45° field of view:
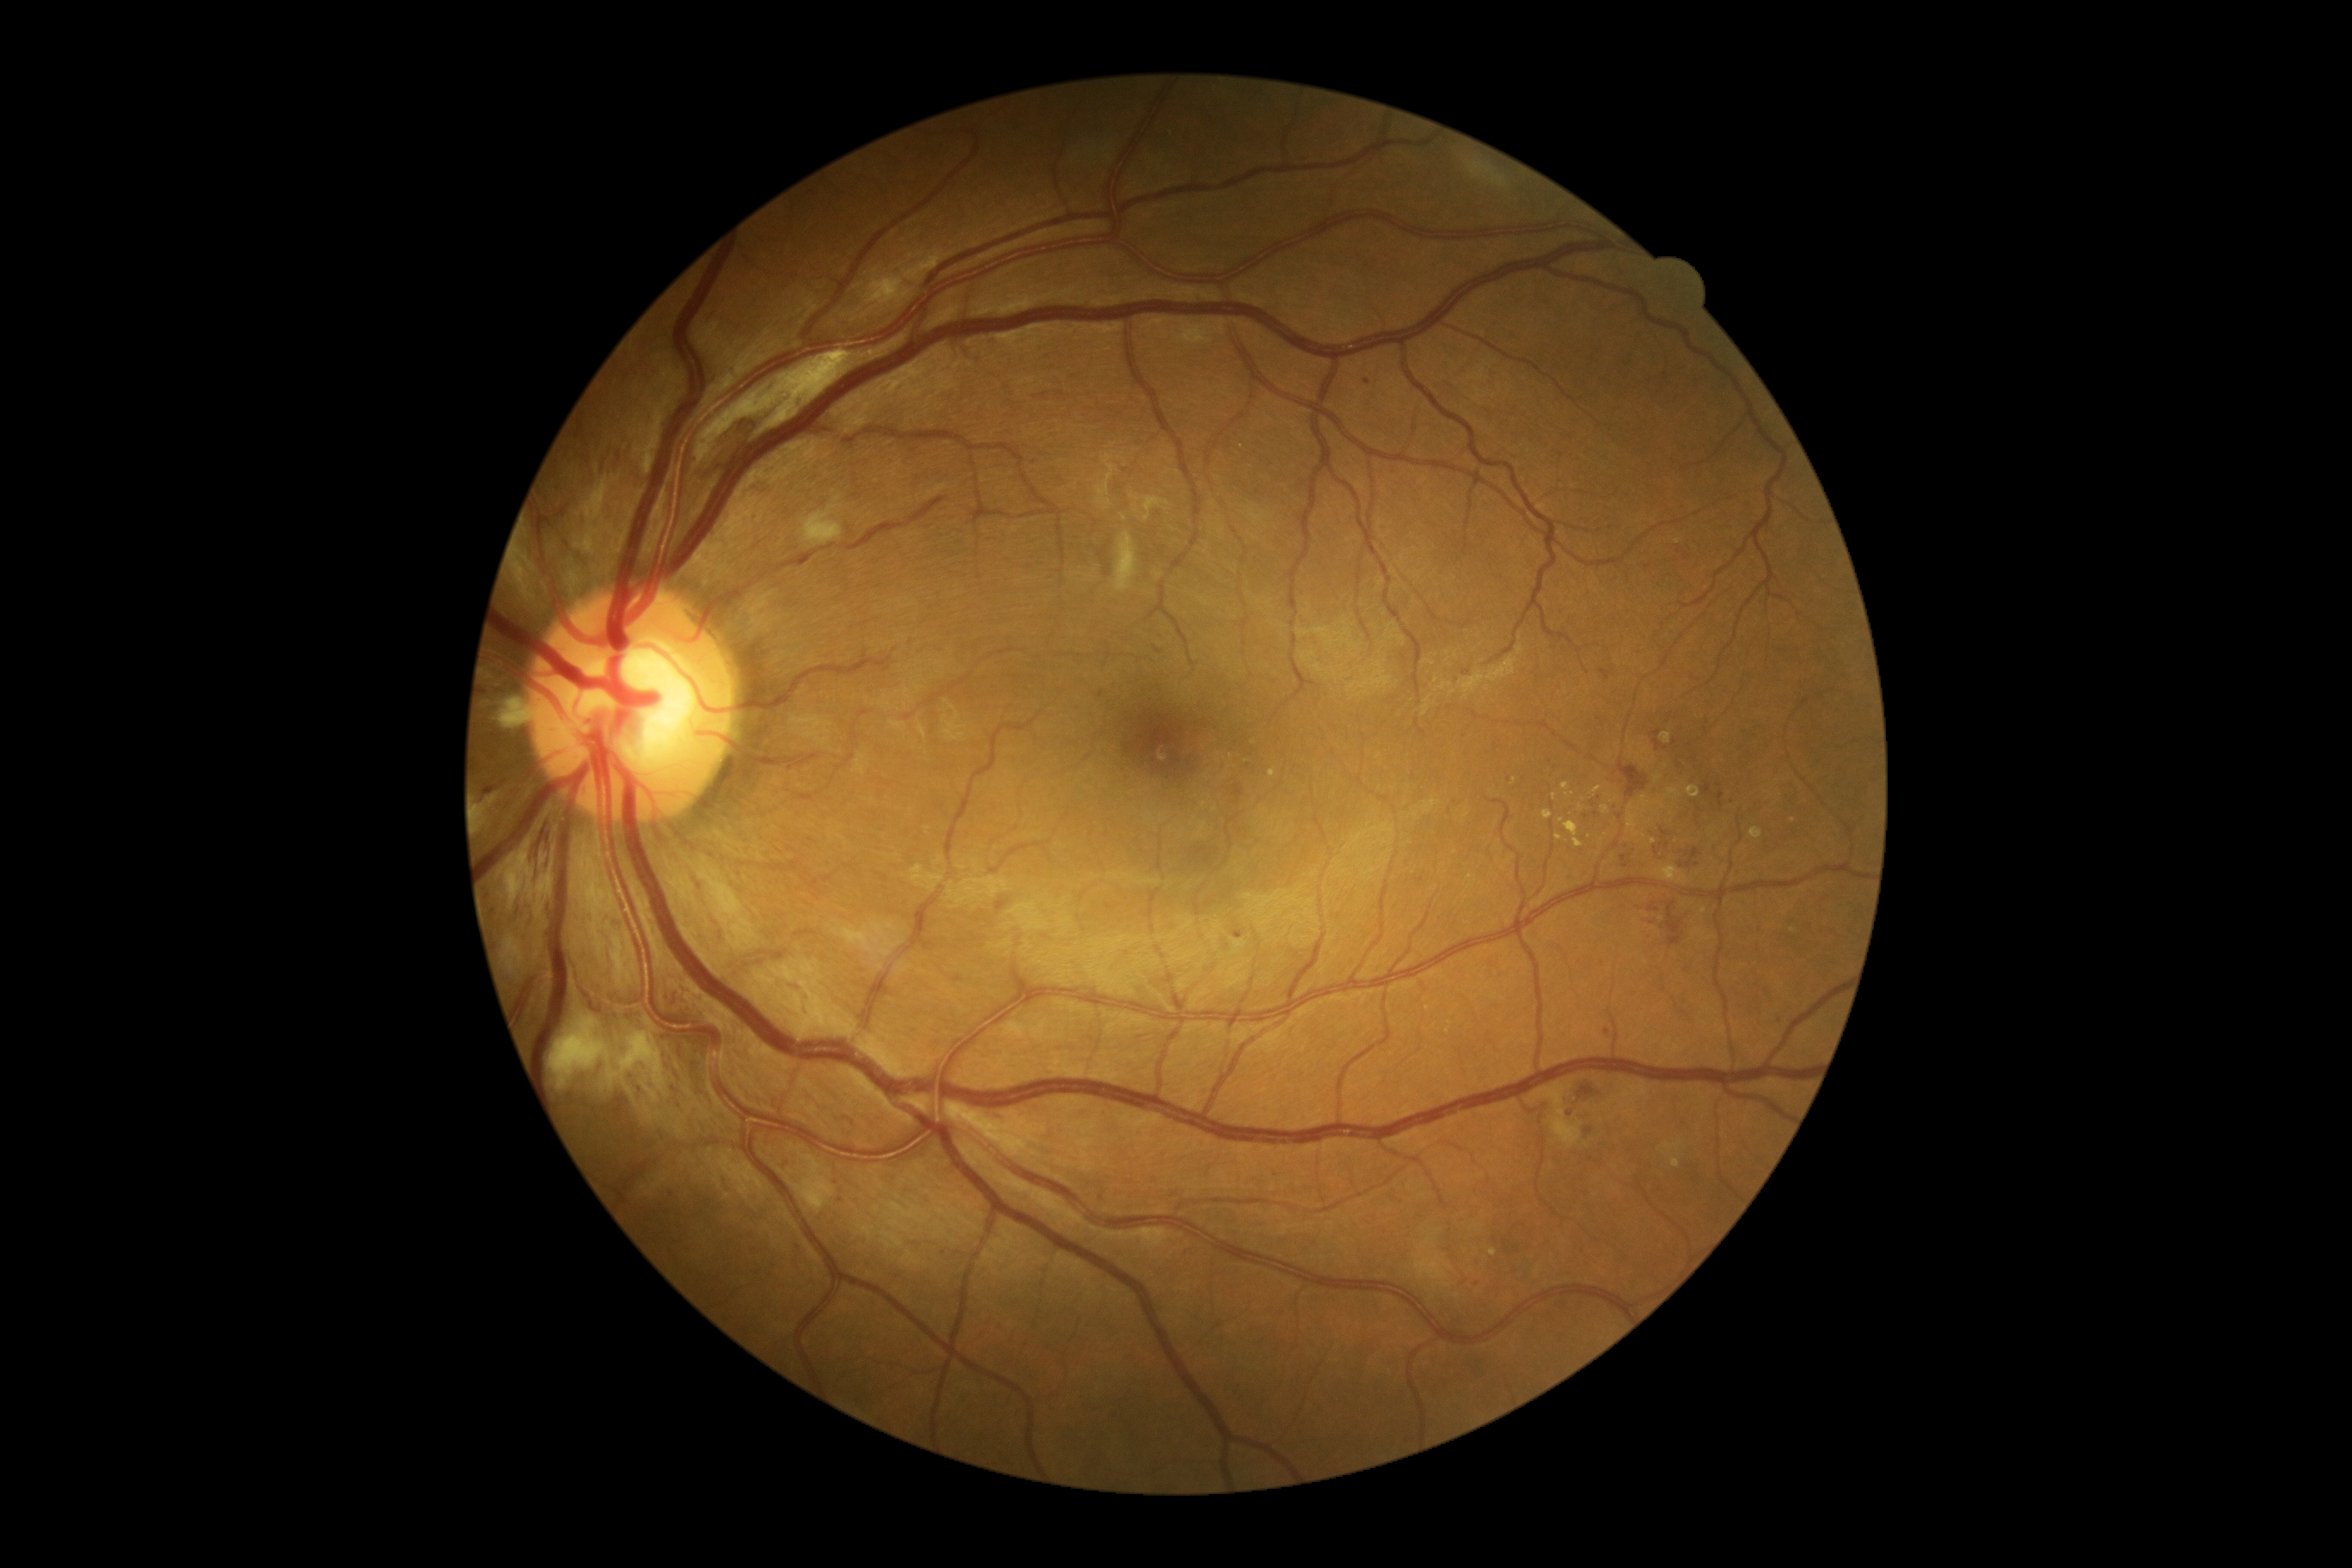
DR grade is 2/4; non-proliferative diabetic retinopathy. MAs include lesions at (left=1155, top=647, right=1163, bottom=654) | (left=683, top=998, right=692, bottom=1005) | (left=1705, top=785, right=1712, bottom=795) | (left=1717, top=792, right=1725, bottom=807) | (left=484, top=790, right=494, bottom=793) | (left=1234, top=933, right=1244, bottom=938) | (left=783, top=1161, right=788, bottom=1170). Smaller MAs around [493, 913] | [671, 995] | [1780, 1022] | [1606, 1031] | [1477, 1285] | [1679, 766] | [836, 1183] | [1035, 462] | [1467, 673] | [1457, 681] | [1596, 814] | [1479, 1267] | [640, 1091]. EXs include lesions at (left=1562, top=783, right=1571, bottom=790) | (left=1672, top=1160, right=1681, bottom=1168) | (left=1655, top=867, right=1689, bottom=885) | (left=1543, top=811, right=1553, bottom=821) | (left=1512, top=778, right=1517, bottom=787) | (left=1565, top=793, right=1574, bottom=797) | (left=1268, top=769, right=1277, bottom=778). Smaller EXs around [1554, 796] | [1703, 911] | [1448, 1030] | [1644, 835] | [1654, 841]. SEs include lesions at (left=498, top=694, right=534, bottom=726) | (left=585, top=530, right=597, bottom=553) | (left=804, top=506, right=842, bottom=546) | (left=549, top=1017, right=670, bottom=1105) | (left=778, top=1144, right=835, bottom=1213) | (left=1134, top=505, right=1141, bottom=515) | (left=577, top=474, right=622, bottom=525) | (left=503, top=936, right=525, bottom=974) | (left=1536, top=1086, right=1584, bottom=1148) | (left=479, top=793, right=494, bottom=830) | (left=513, top=542, right=534, bottom=591). Smaller SEs around [1122, 460].